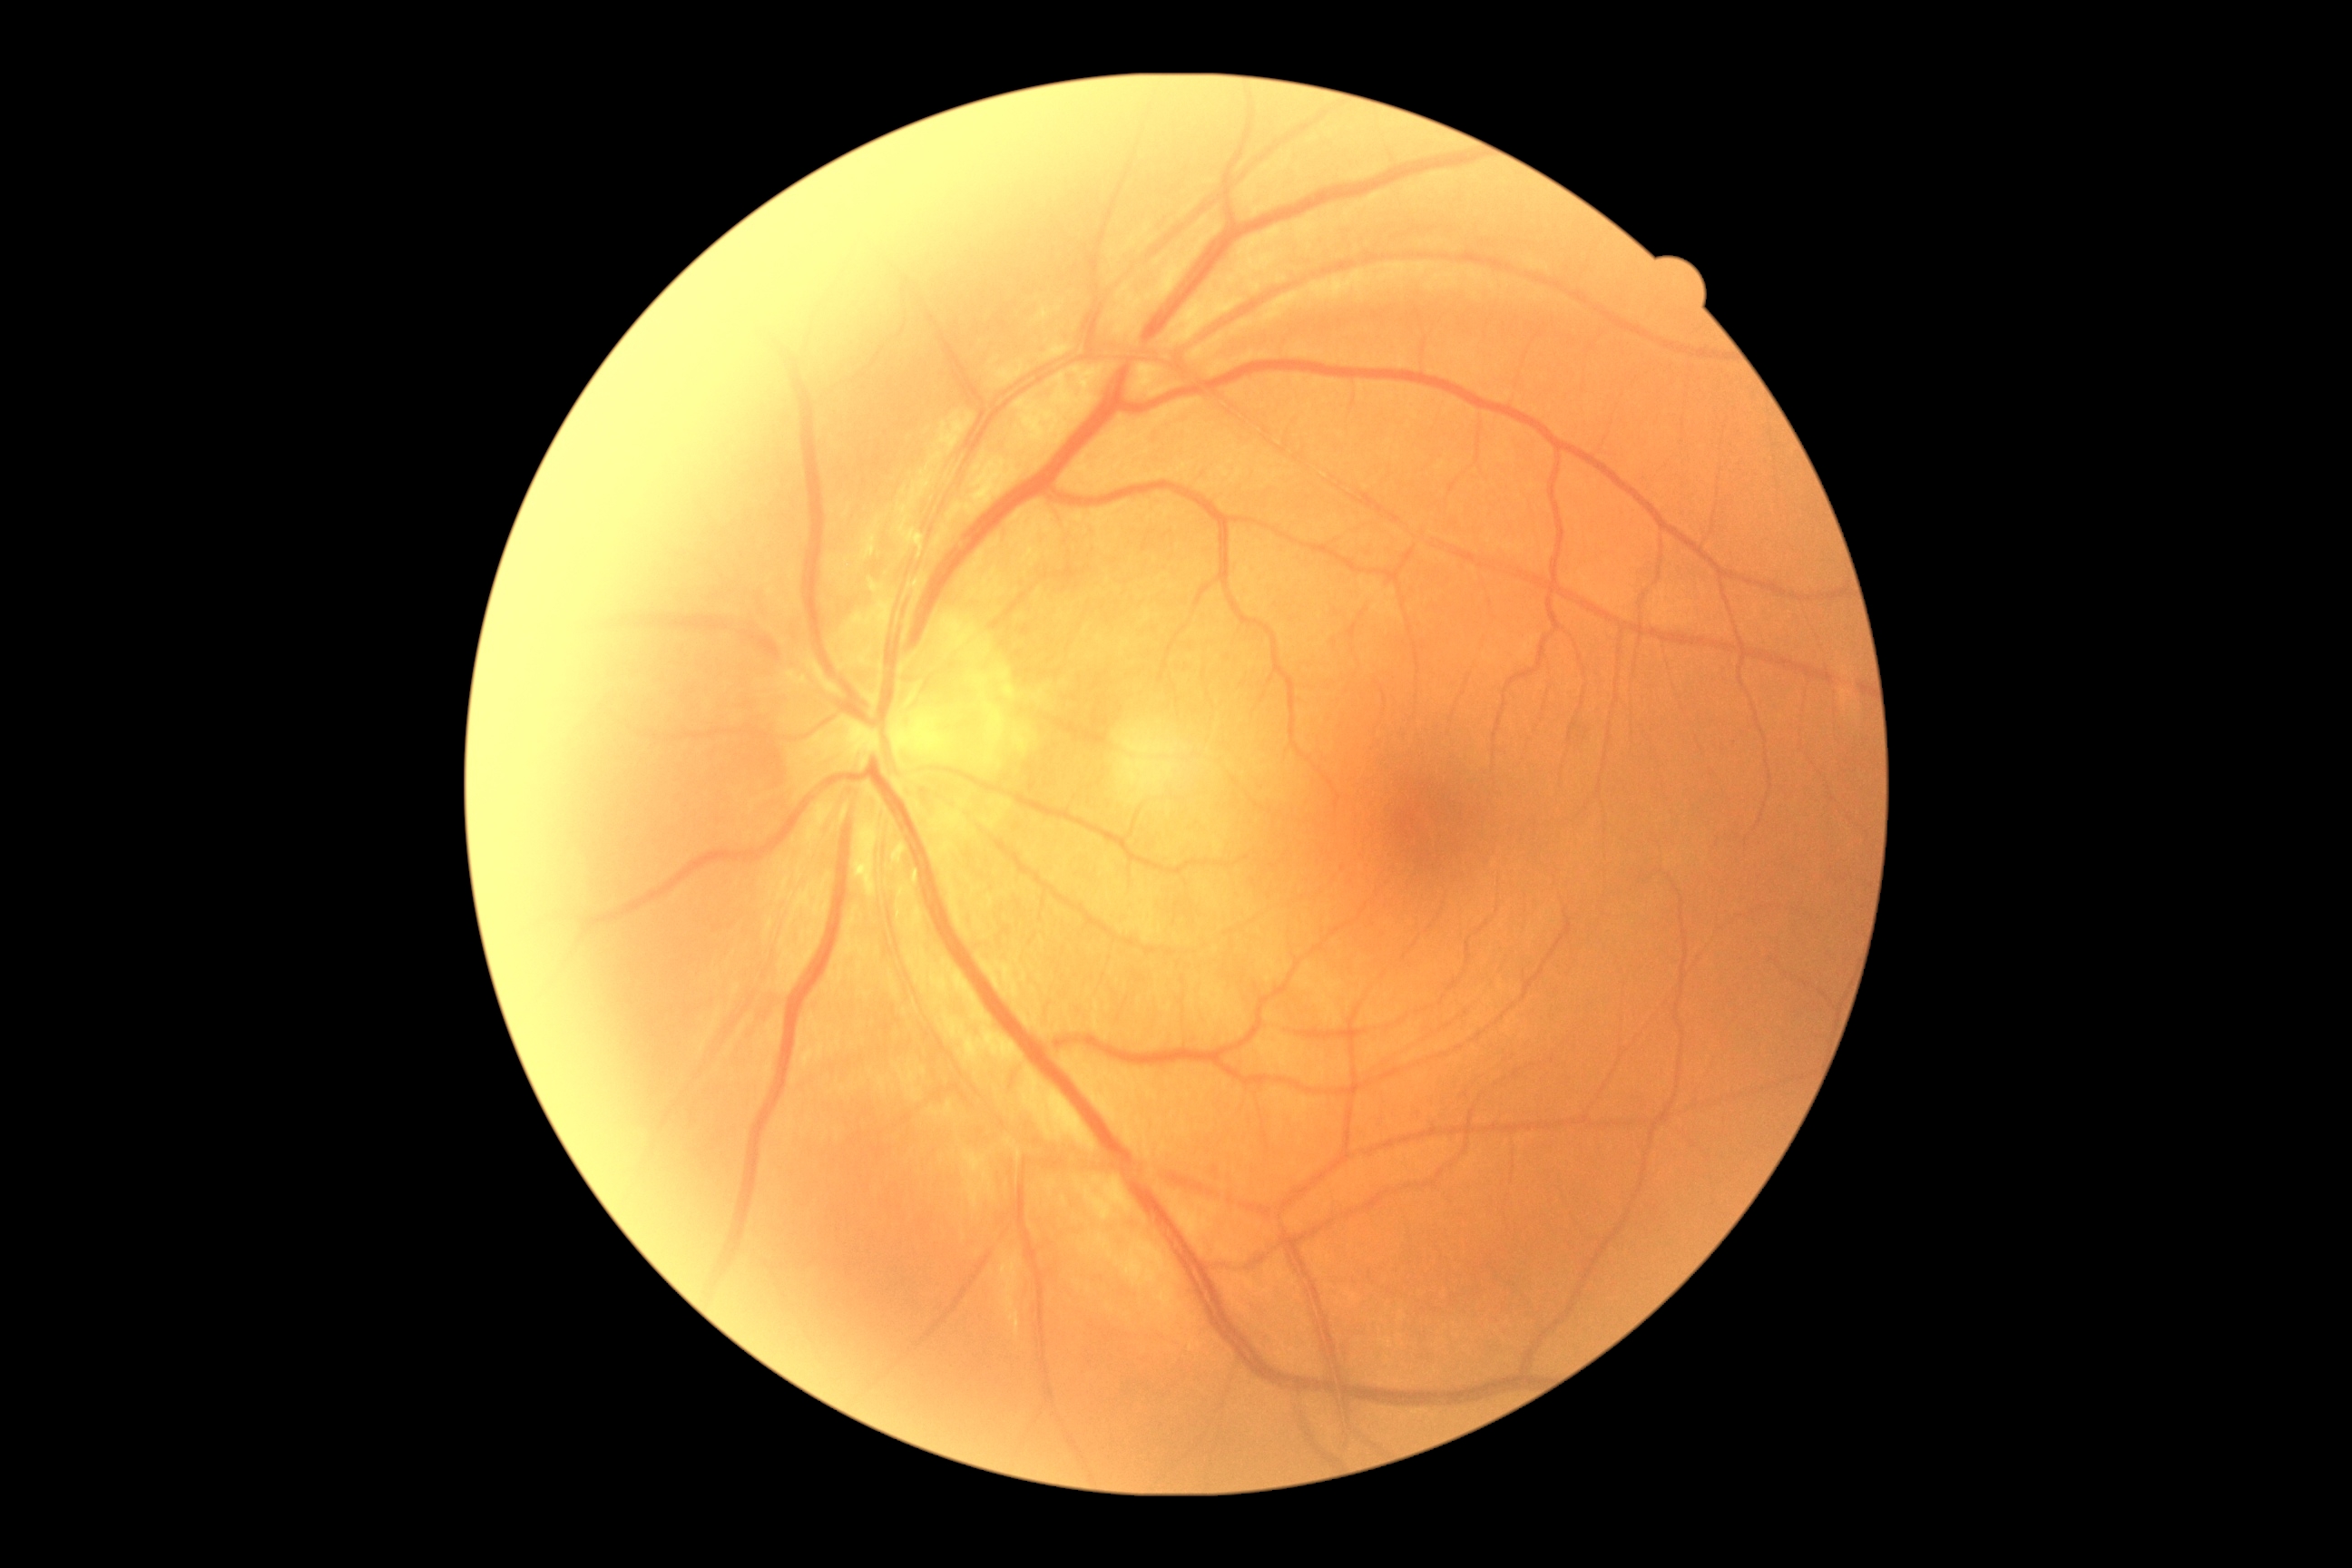
Retinopathy grade is 0 (no apparent retinopathy).